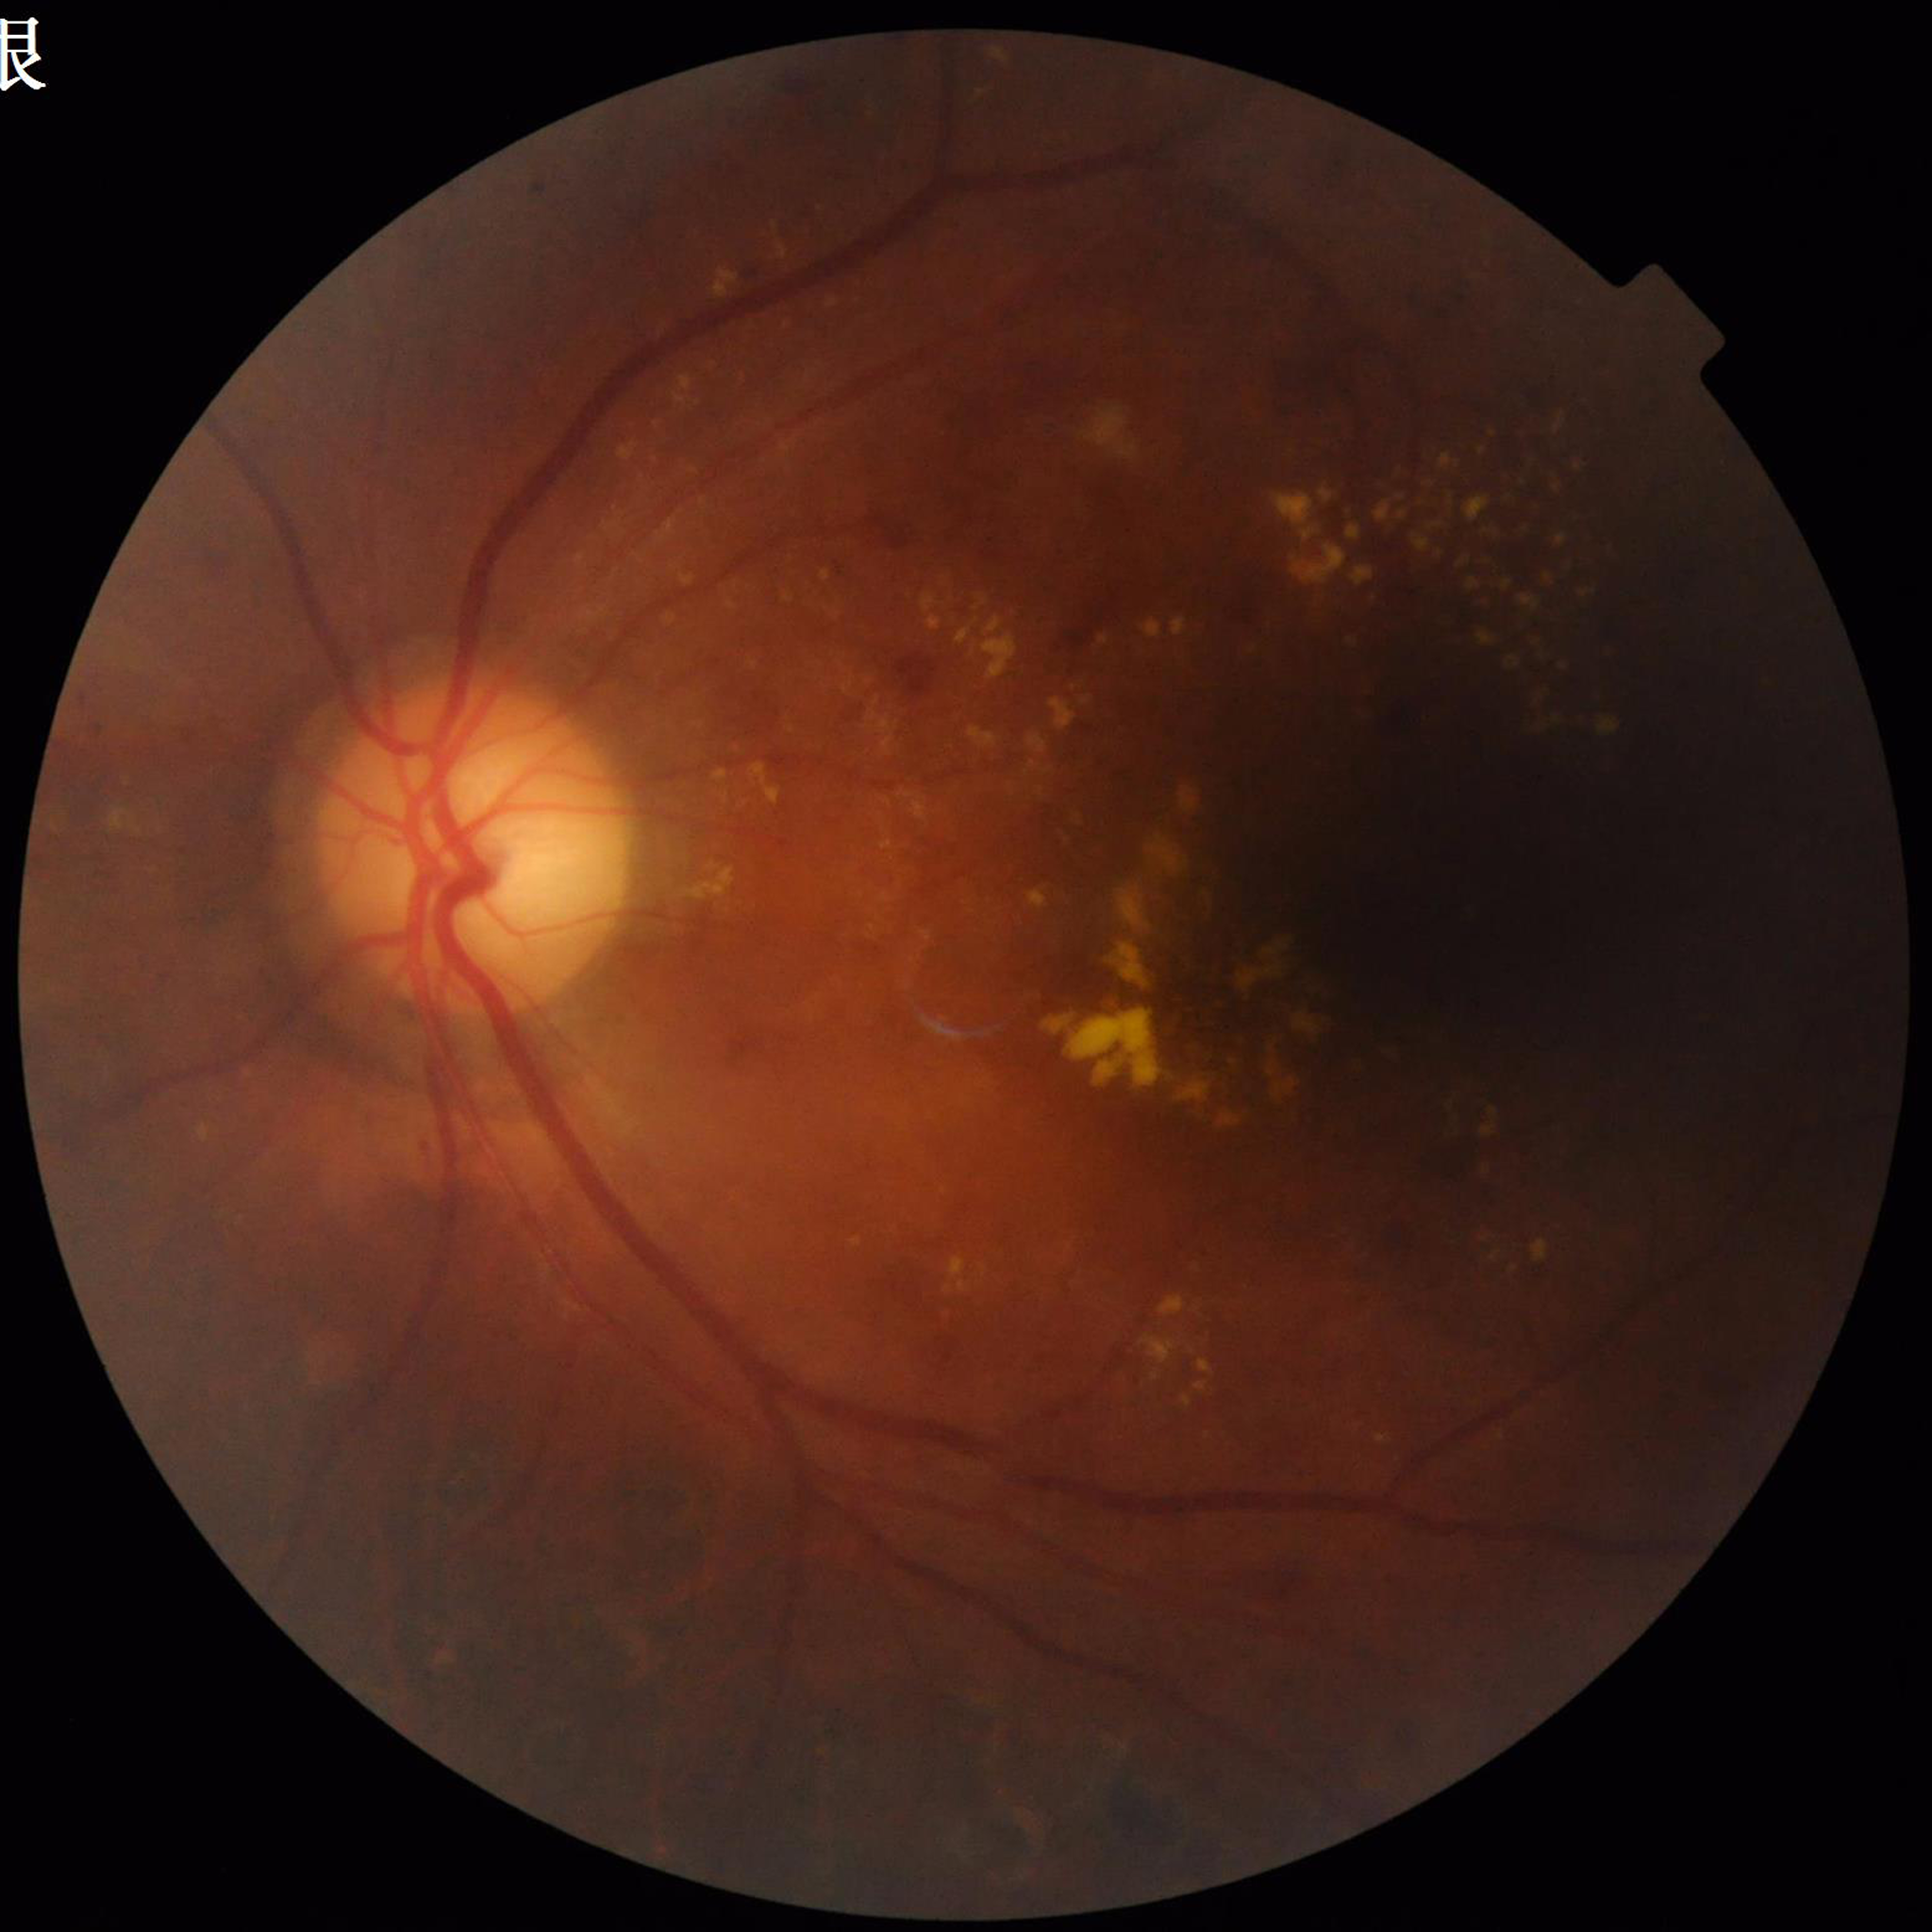 Image quality: poor — illumination/color distortion; Disease: diabetic retinopathy.